Fundus photo: 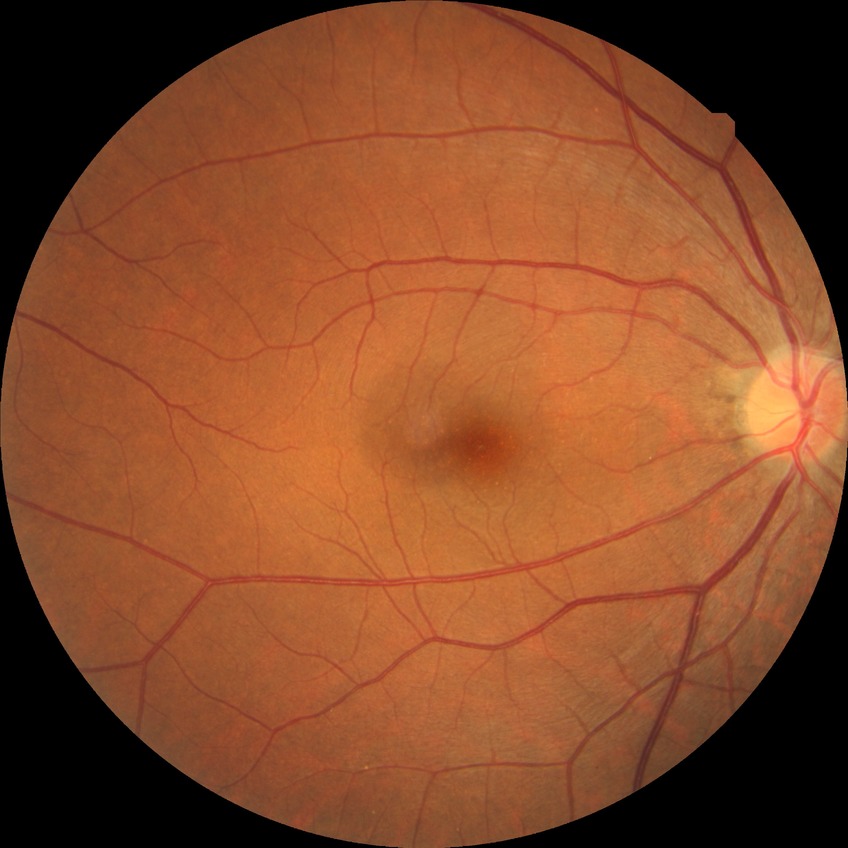 Modified Davis grading: no diabetic retinopathy.